45° field of view.
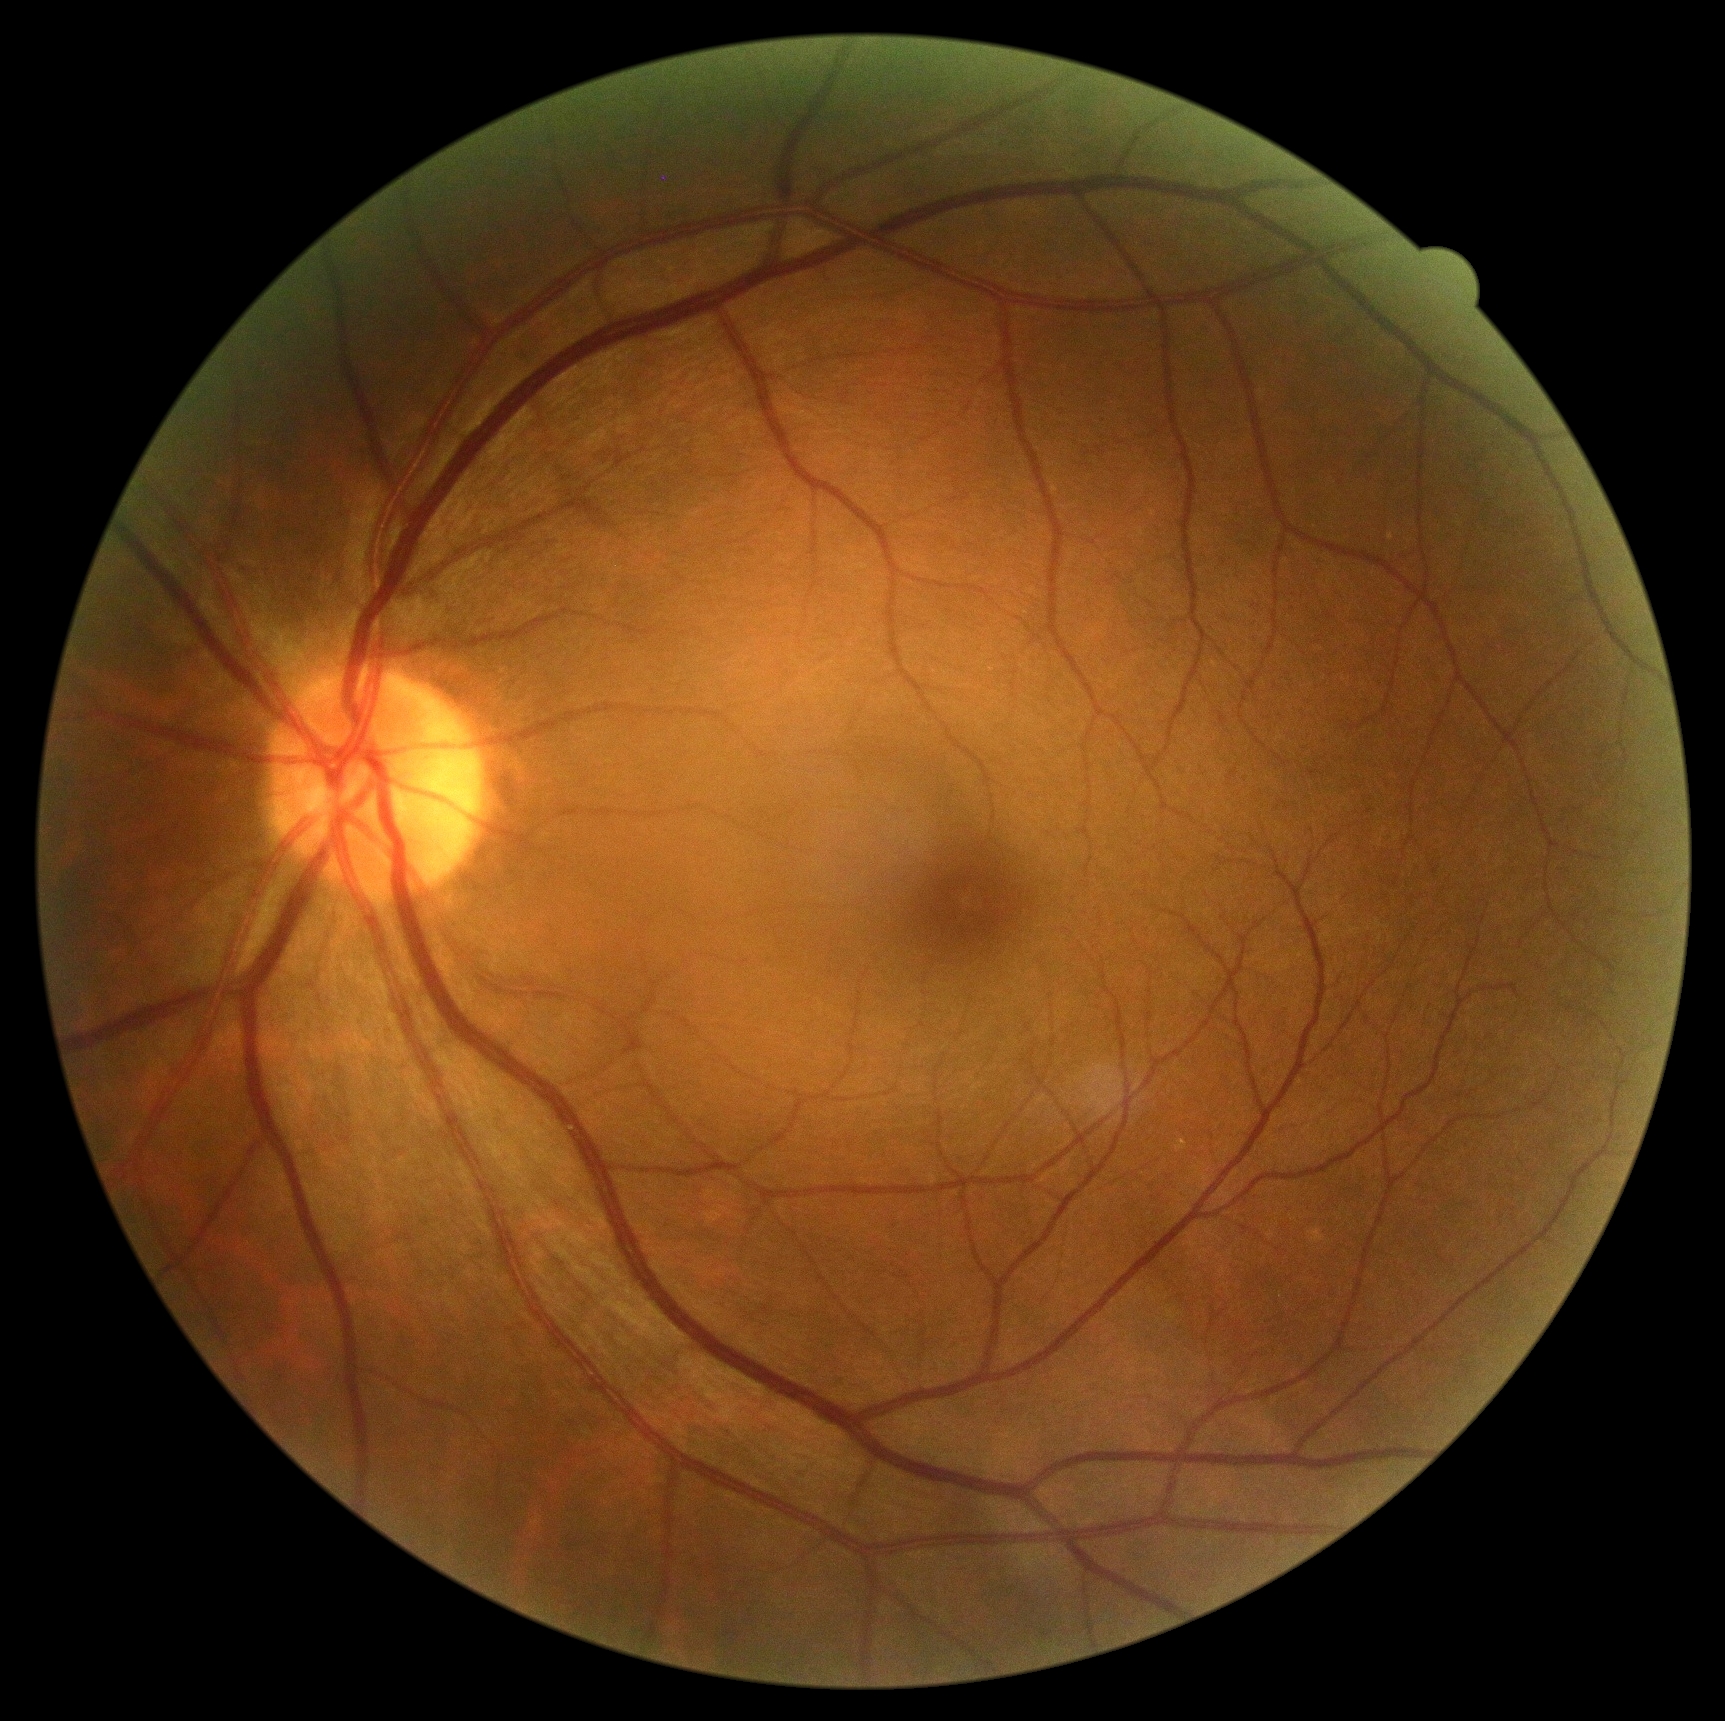

Findings:
- retinopathy — grade 0 (no apparent retinopathy)
- DR impression — no DR findings